No pharmacologic dilation.
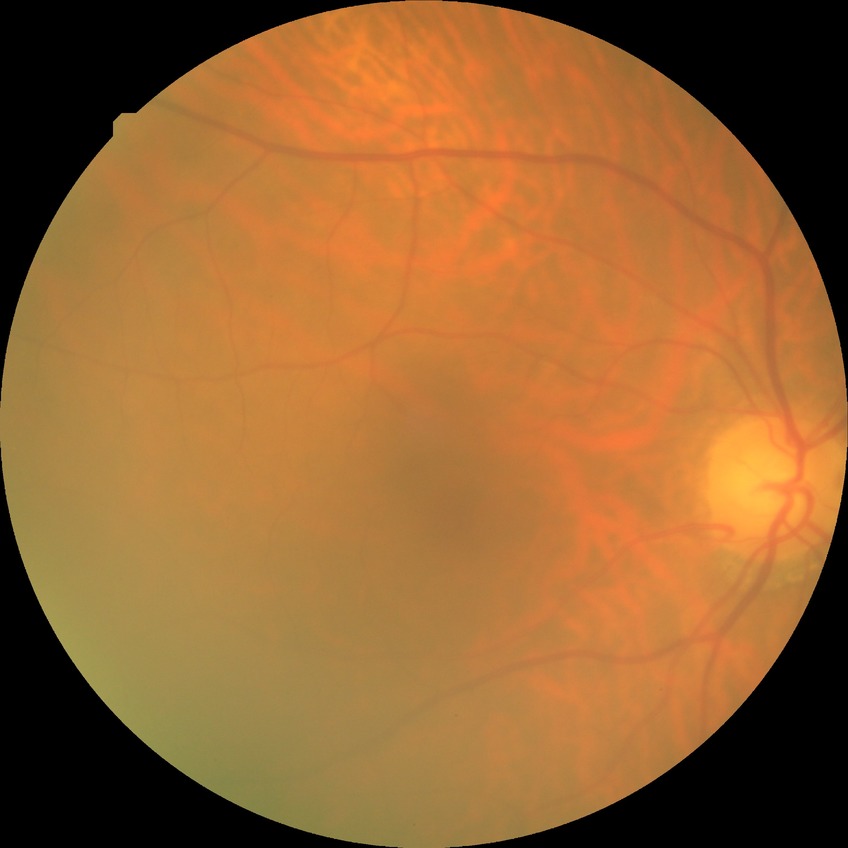 Diabetic retinopathy (DR): NDR (no diabetic retinopathy).